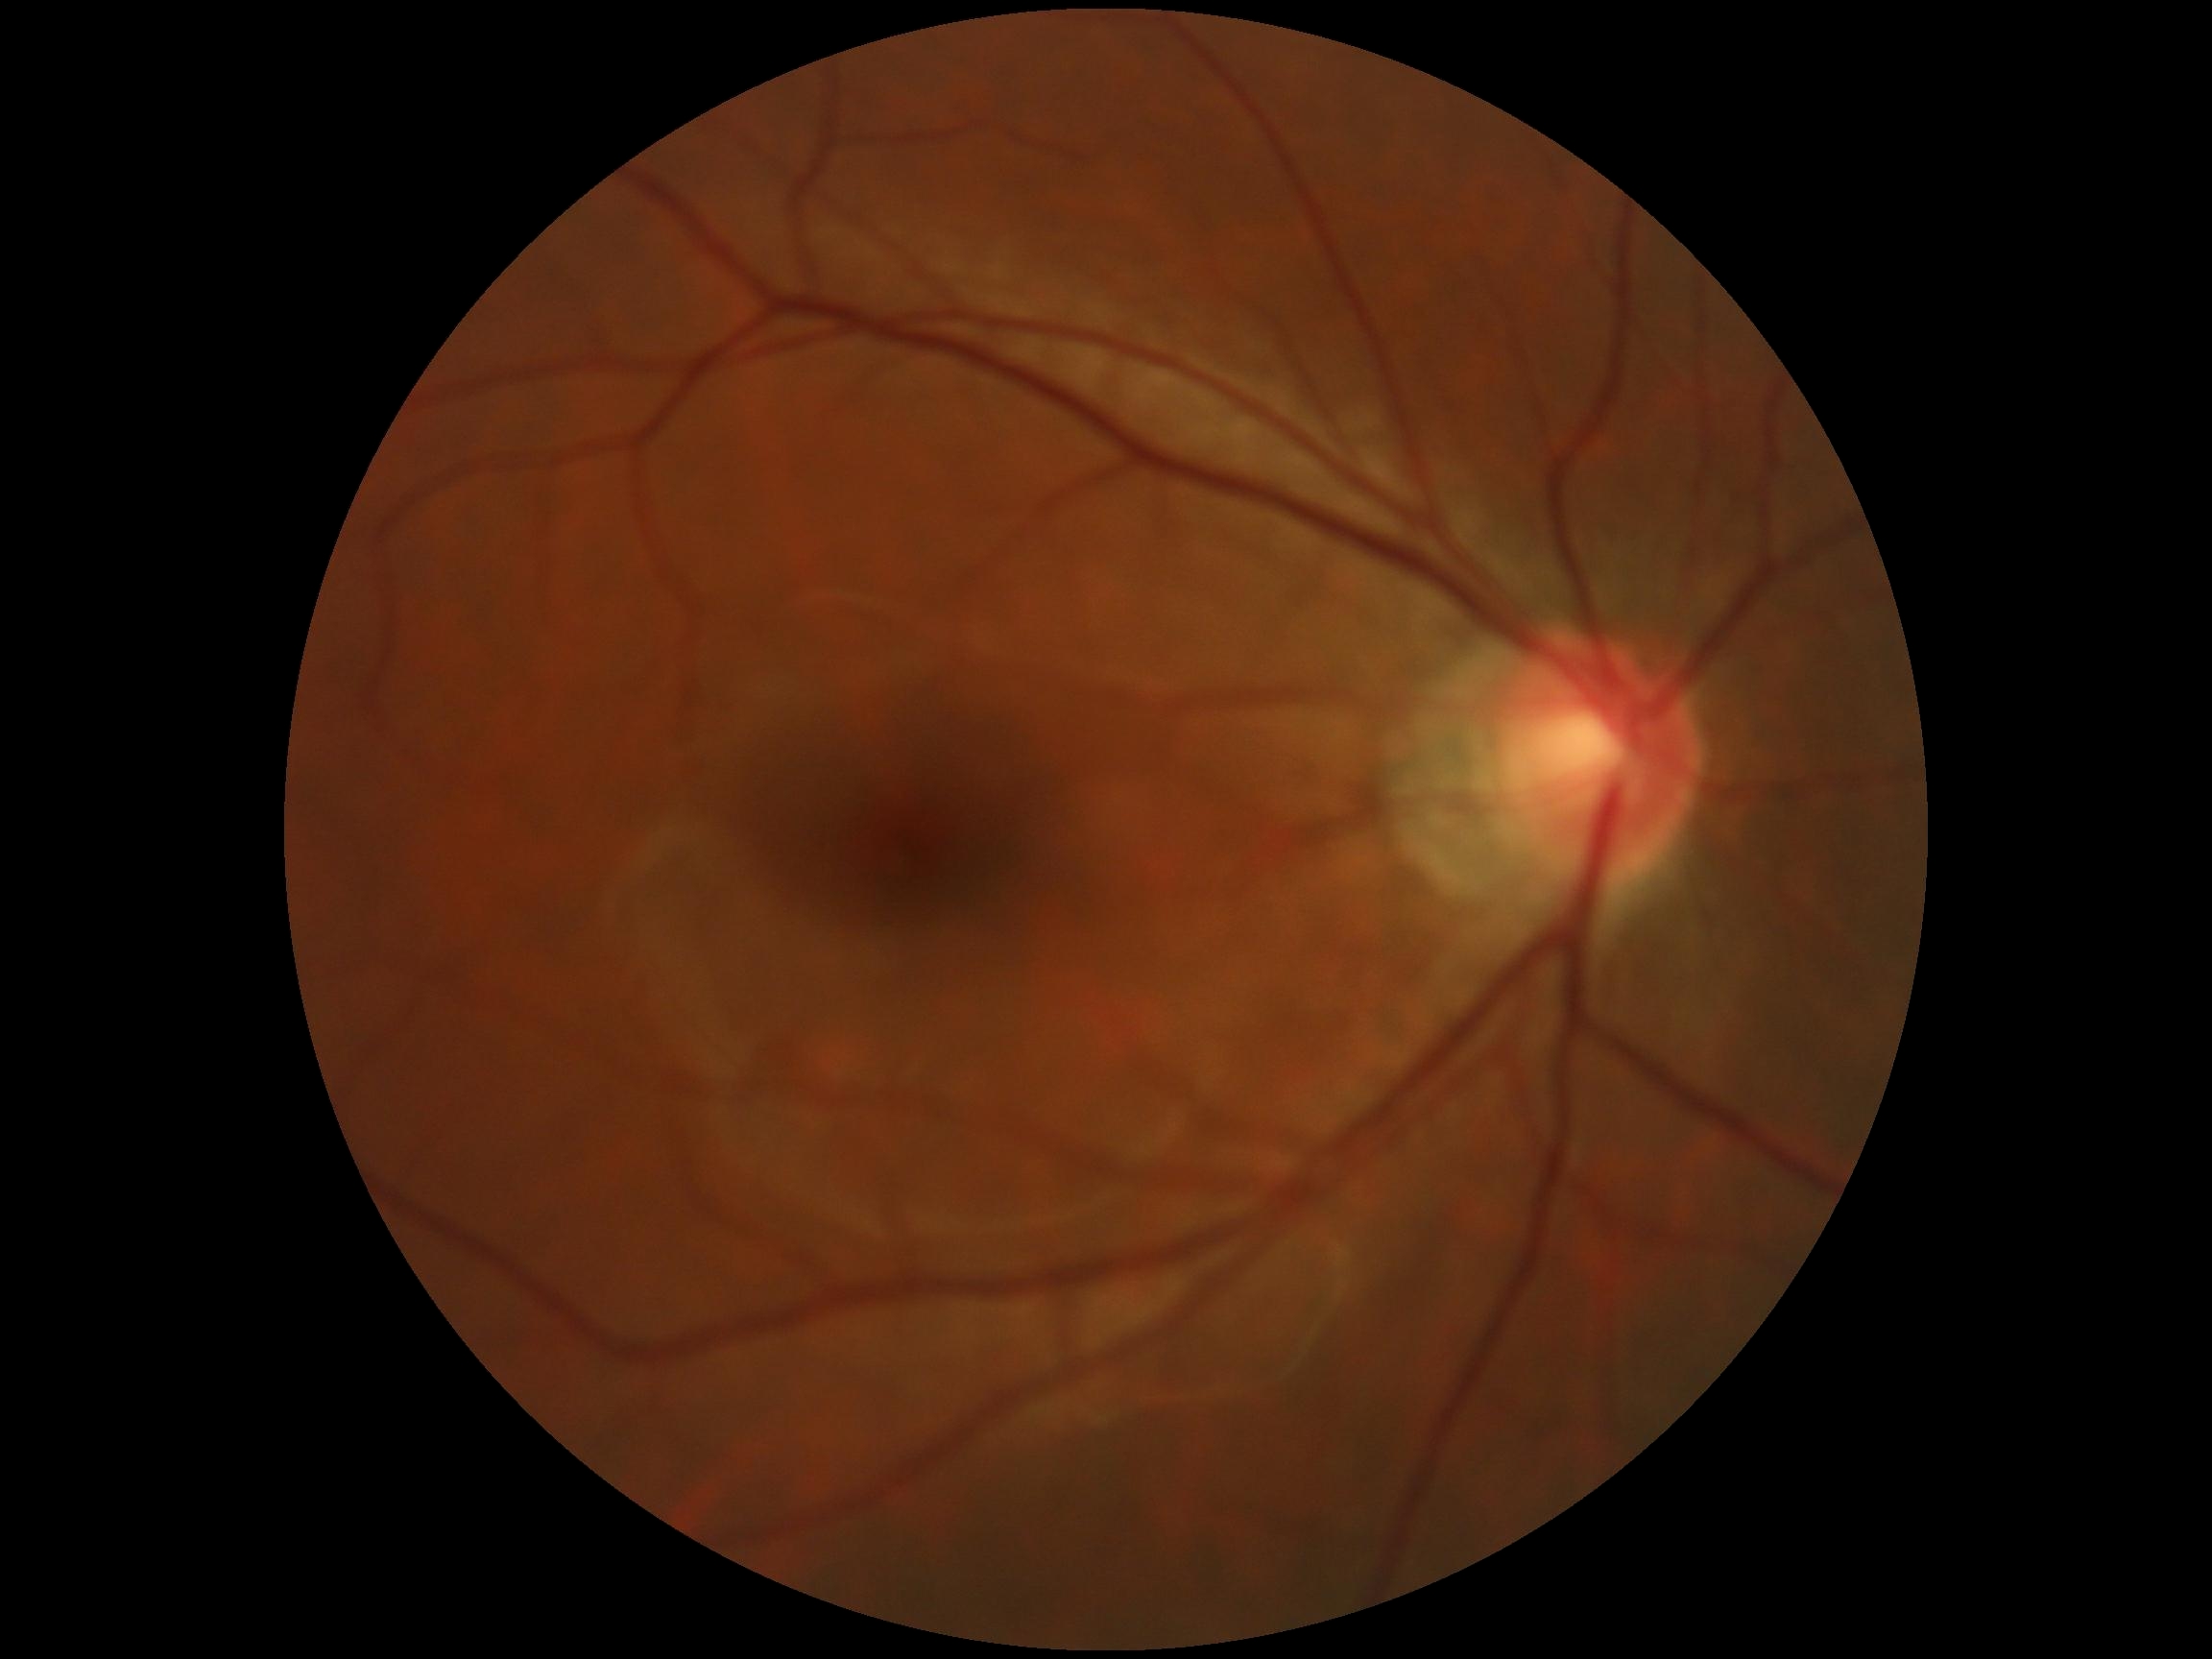 DR is no apparent diabetic retinopathy (grade 0).